45° field of view: 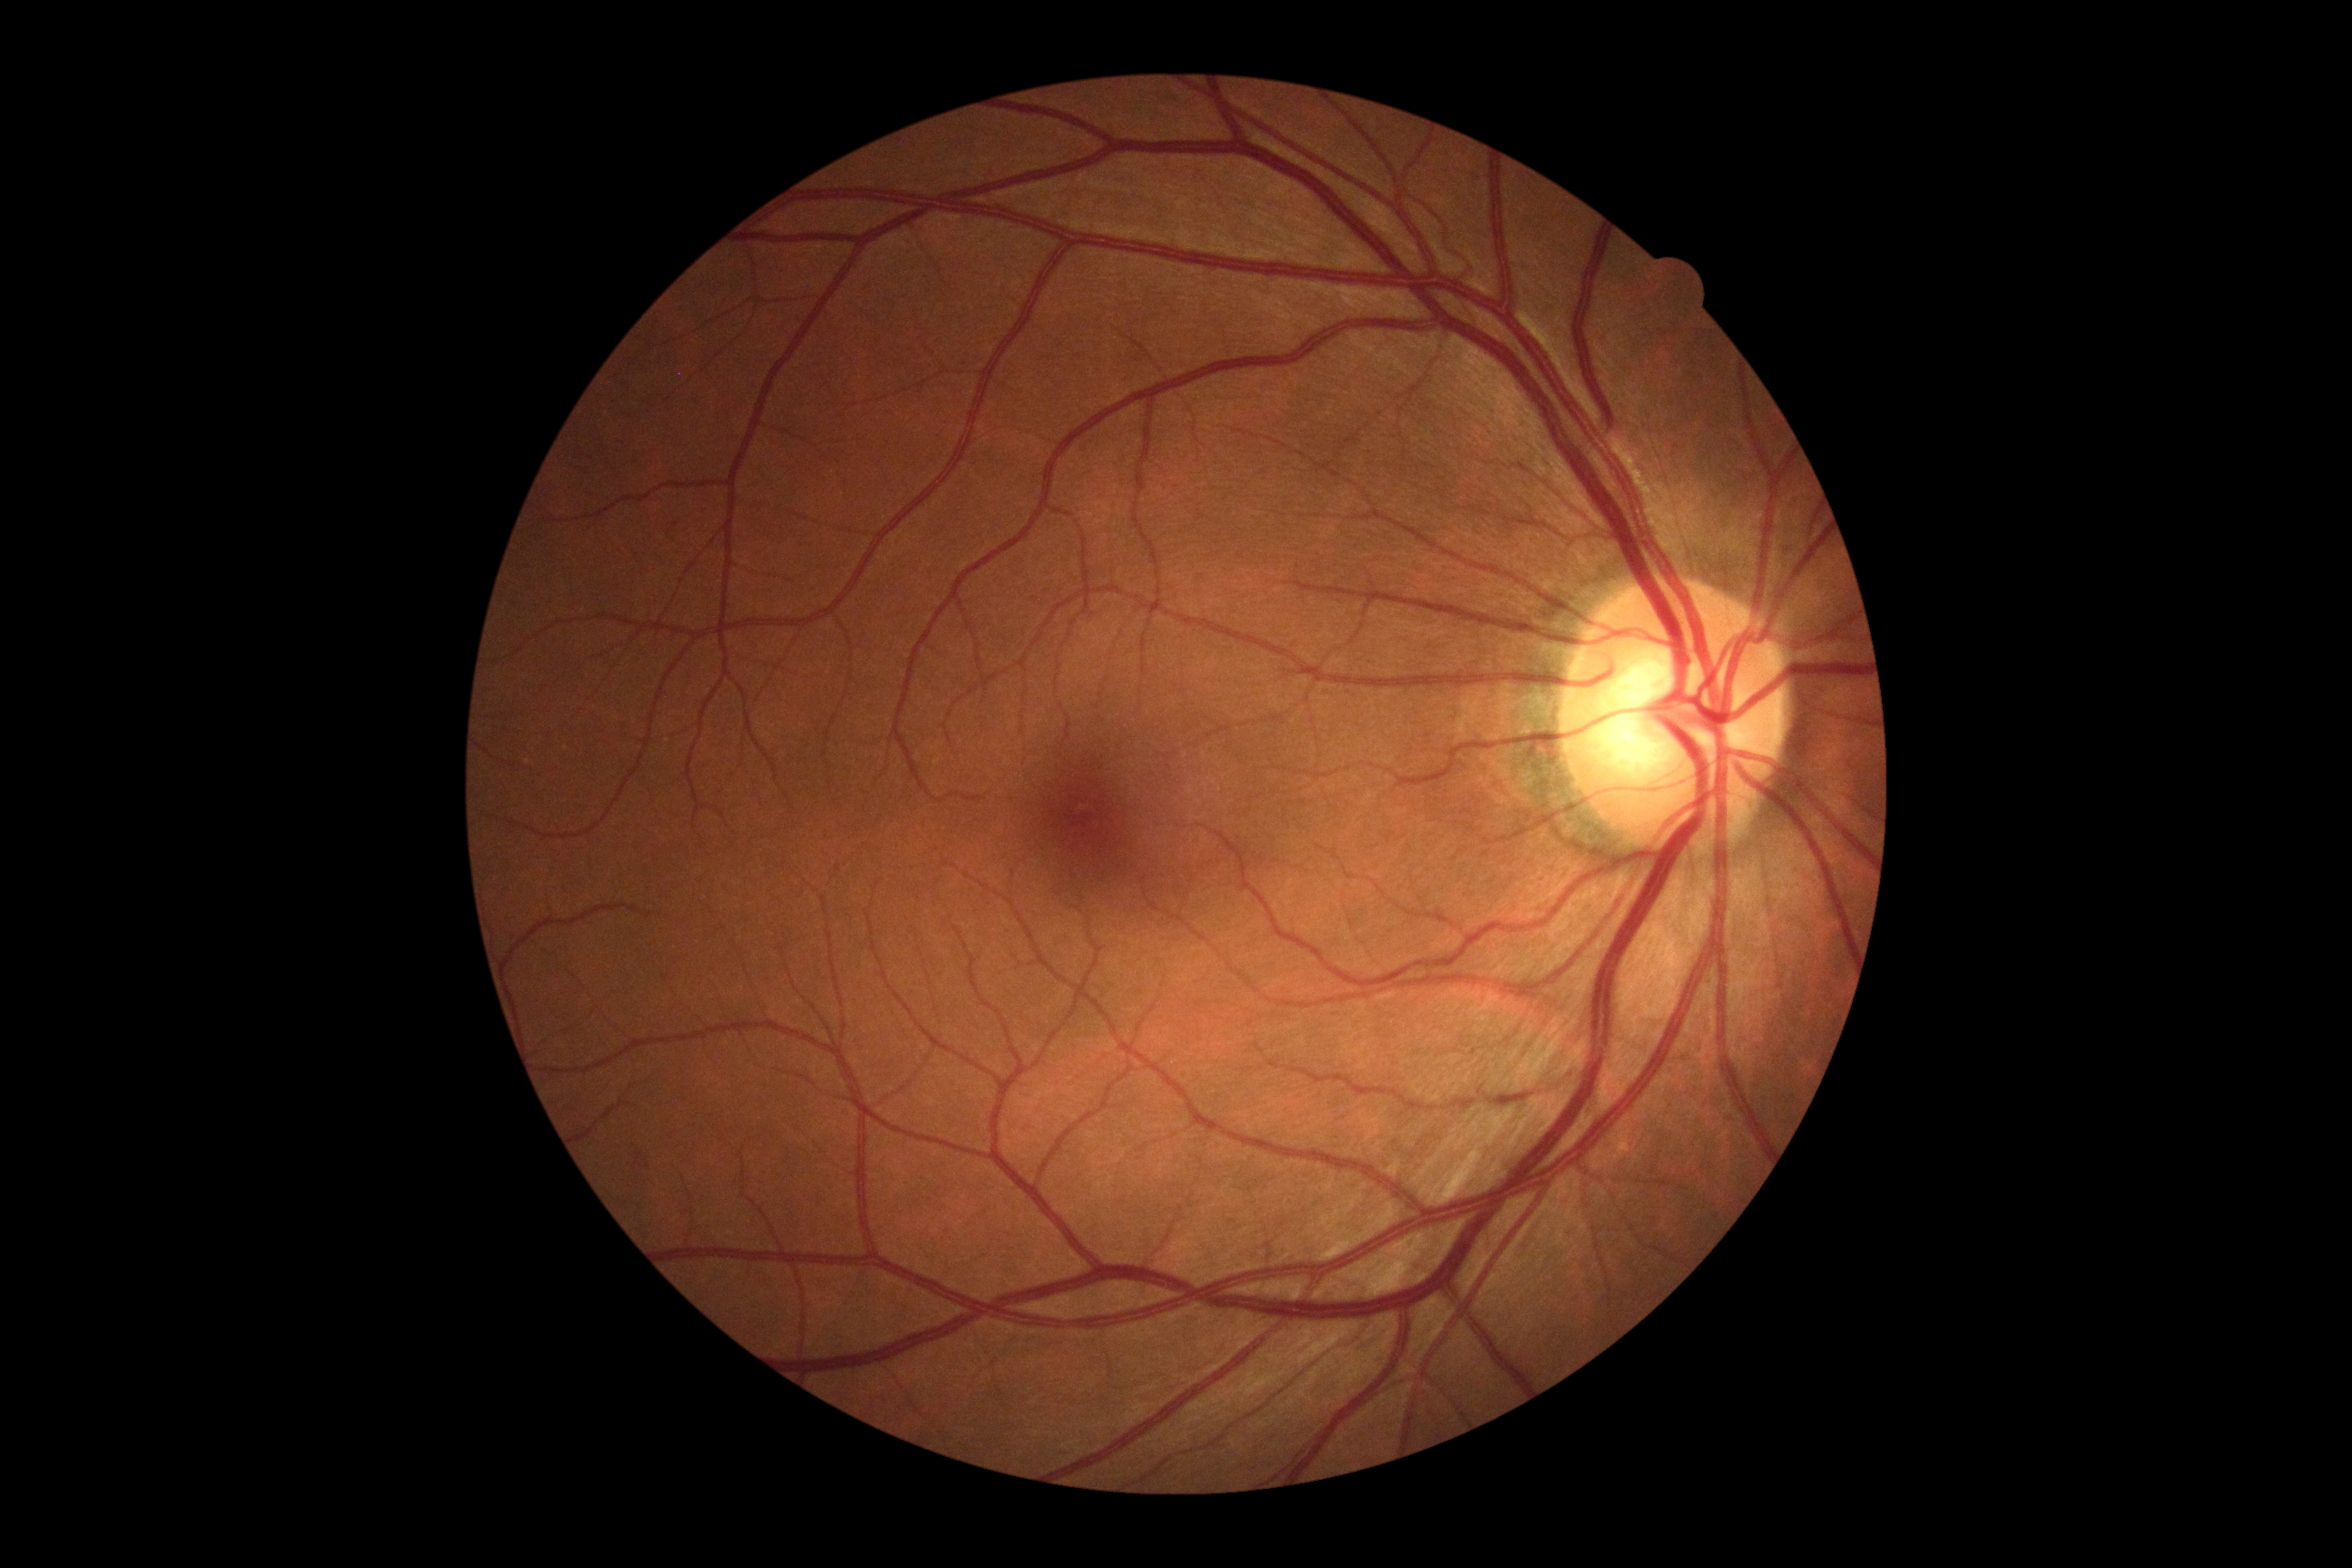

Annotations:
- retinopathy: grade 0 — no visible signs of diabetic retinopathy